Disc-centered fundus crop, captured on a Topcon TRC retinal camera.
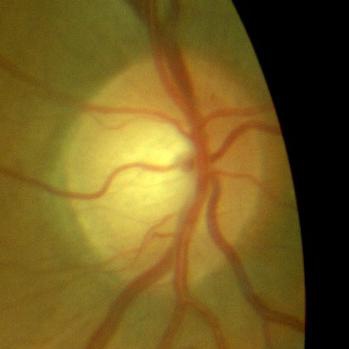 Consistent with no glaucomatous optic neuropathy.